45° field of view; color fundus photograph: 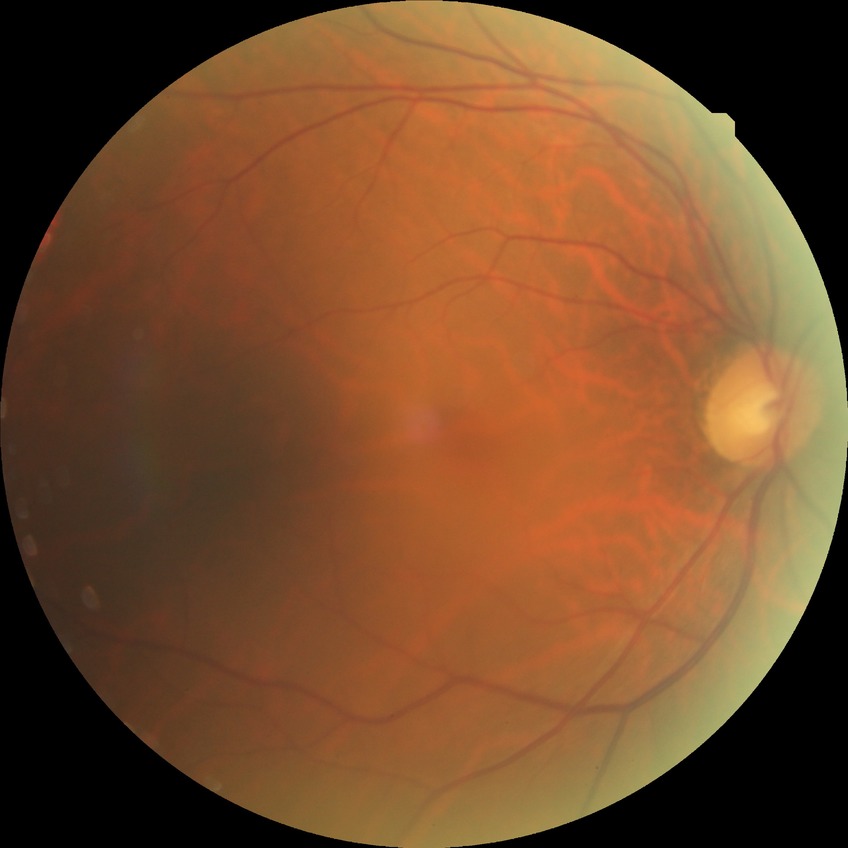 Diabetic retinopathy (DR): NDR (no diabetic retinopathy).